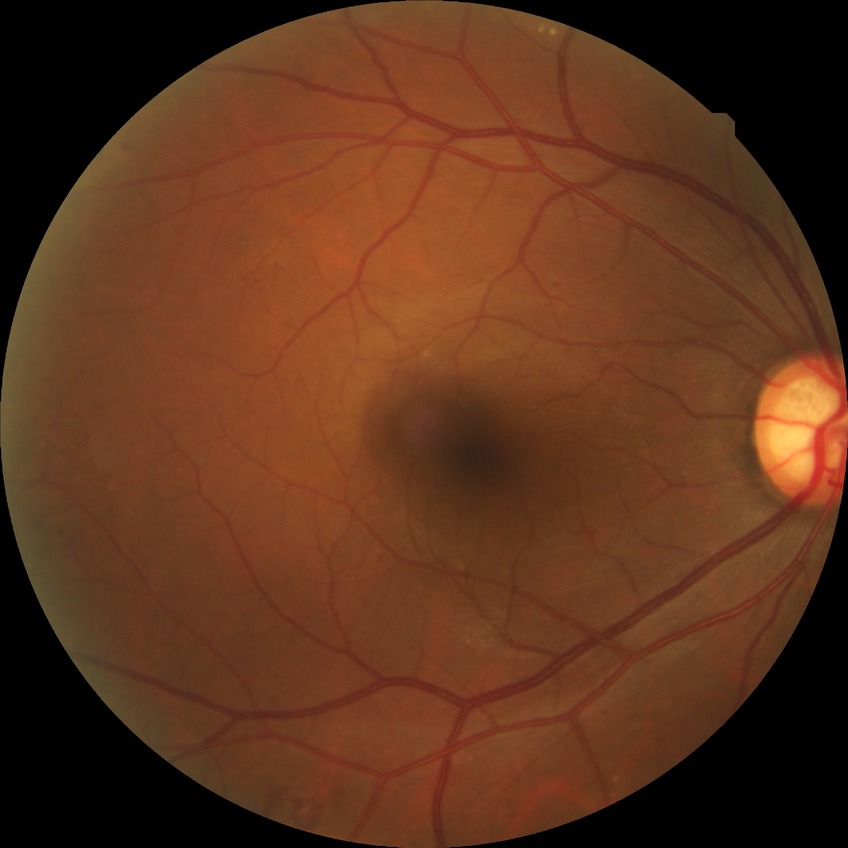
Retinopathy stage: pre-proliferative diabetic retinopathy.